45° FOV, image size 848x848, acquired with a NIDEK AFC-230, without pupil dilation, color fundus photograph: 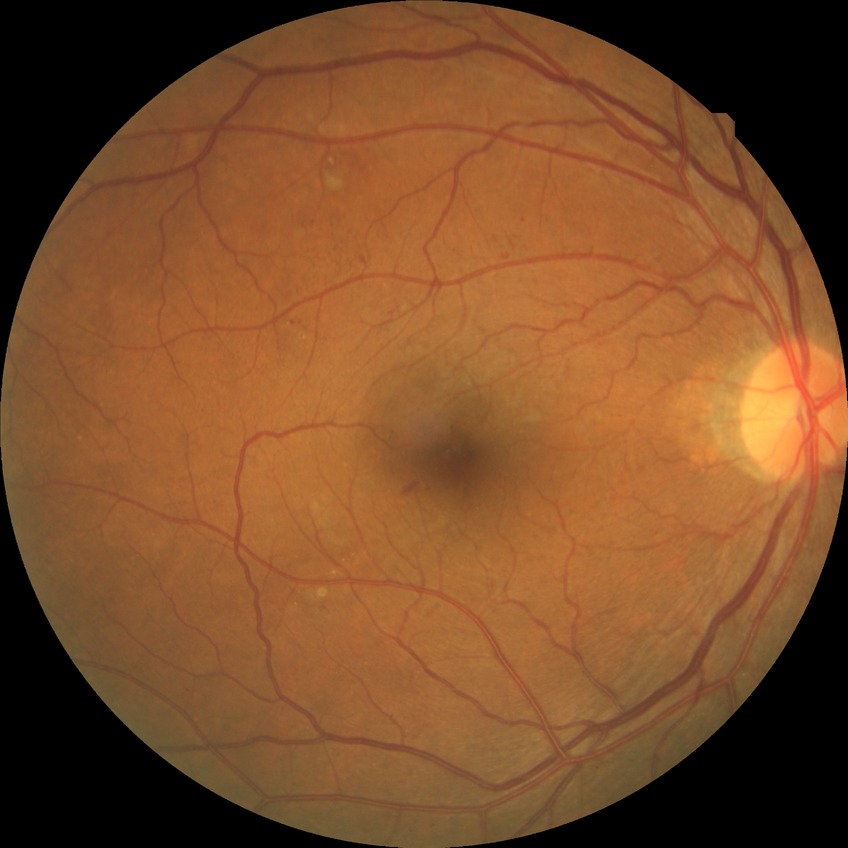 - Davis grading: simple diabetic retinopathy